1932 x 1932 pixels, FOV: 45 degrees — 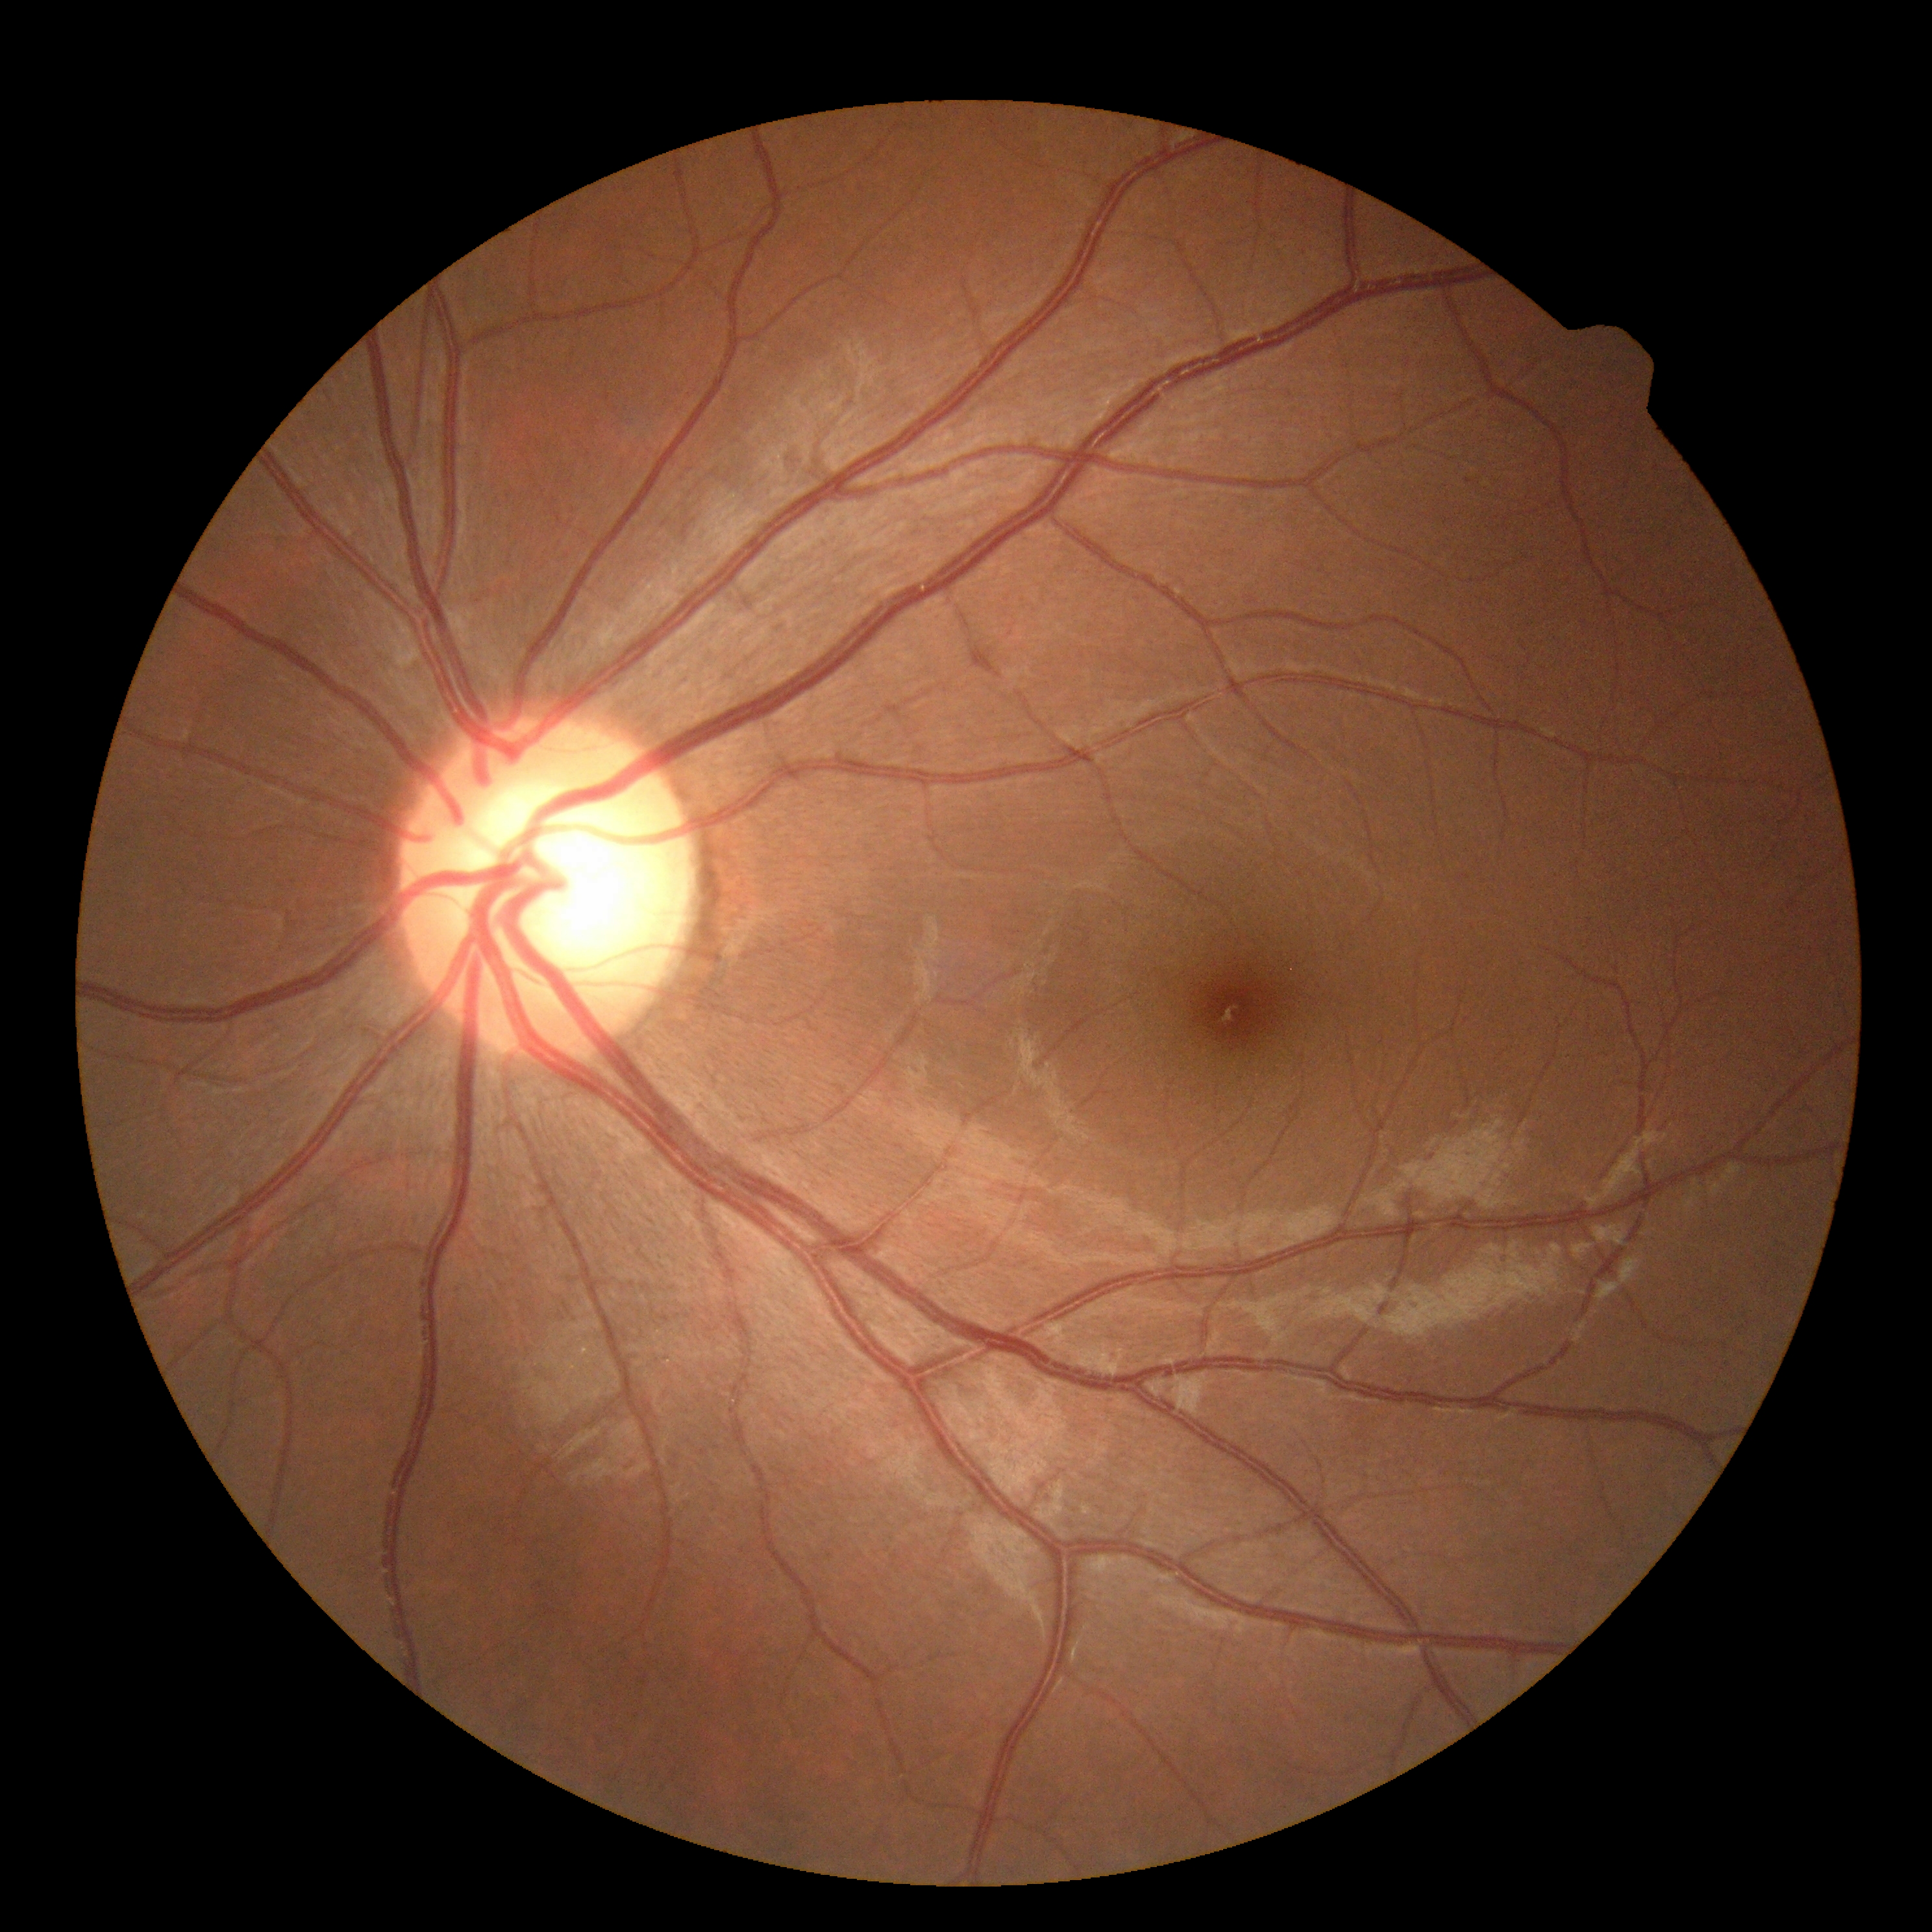

DR severity: 0.